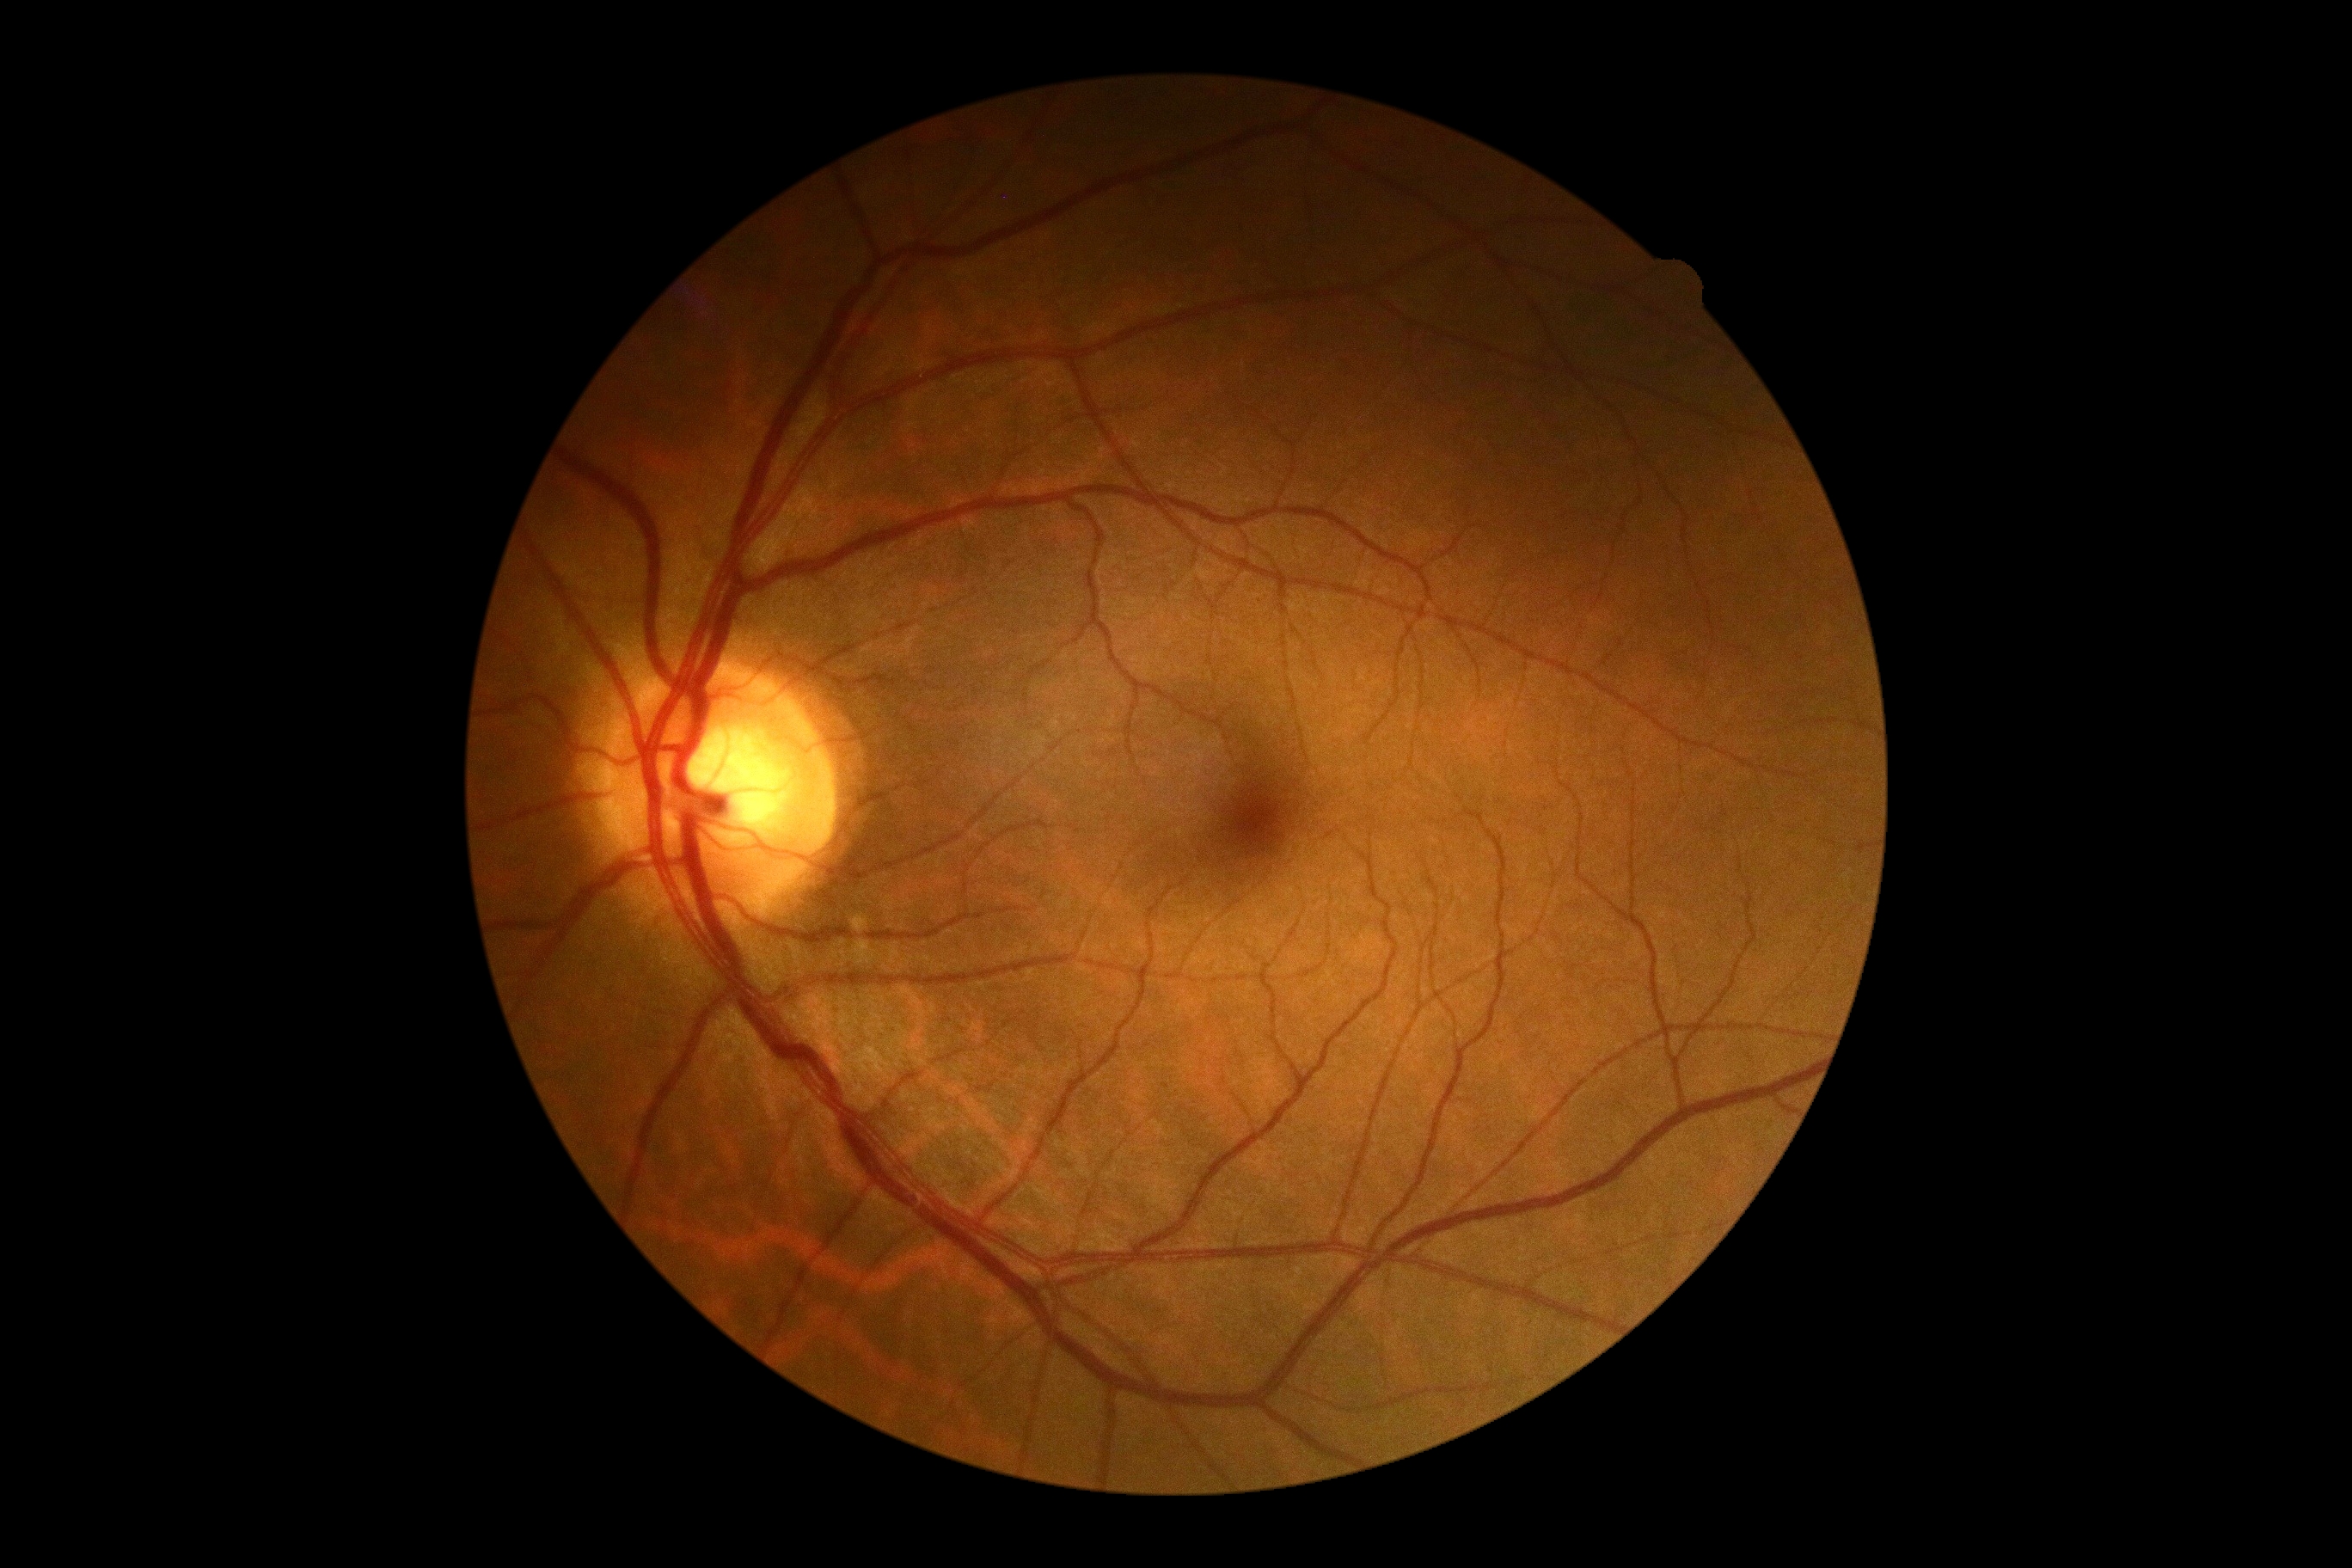 Diabetic retinopathy (DR) is no apparent retinopathy (grade 0).